640 x 480 pixels; Clarity RetCam 3, 130° FOV; wide-field fundus photograph of an infant
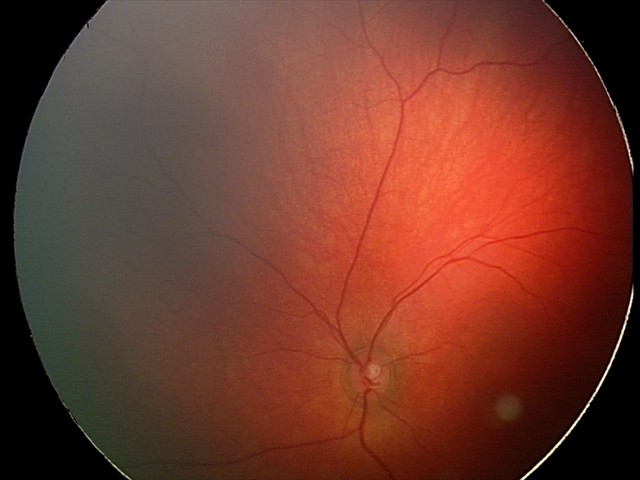

Assessment: retinal hemorrhages.